Acquired on the Phoenix ICON · pediatric wide-field fundus photograph: 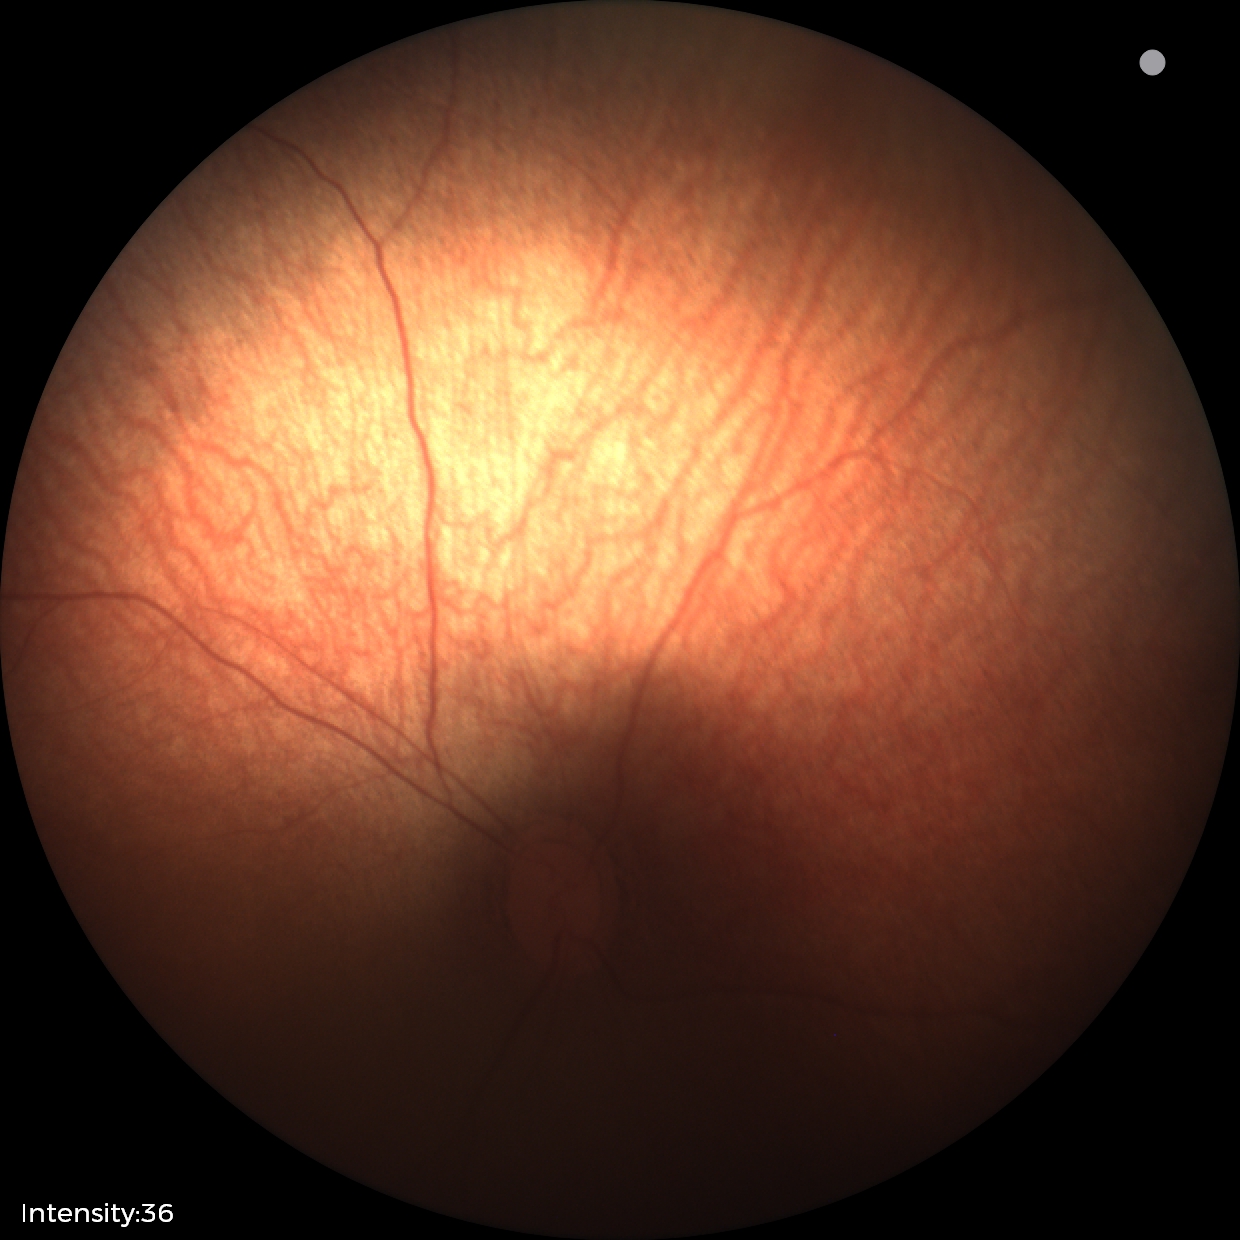 No retinal pathology identified on screening.